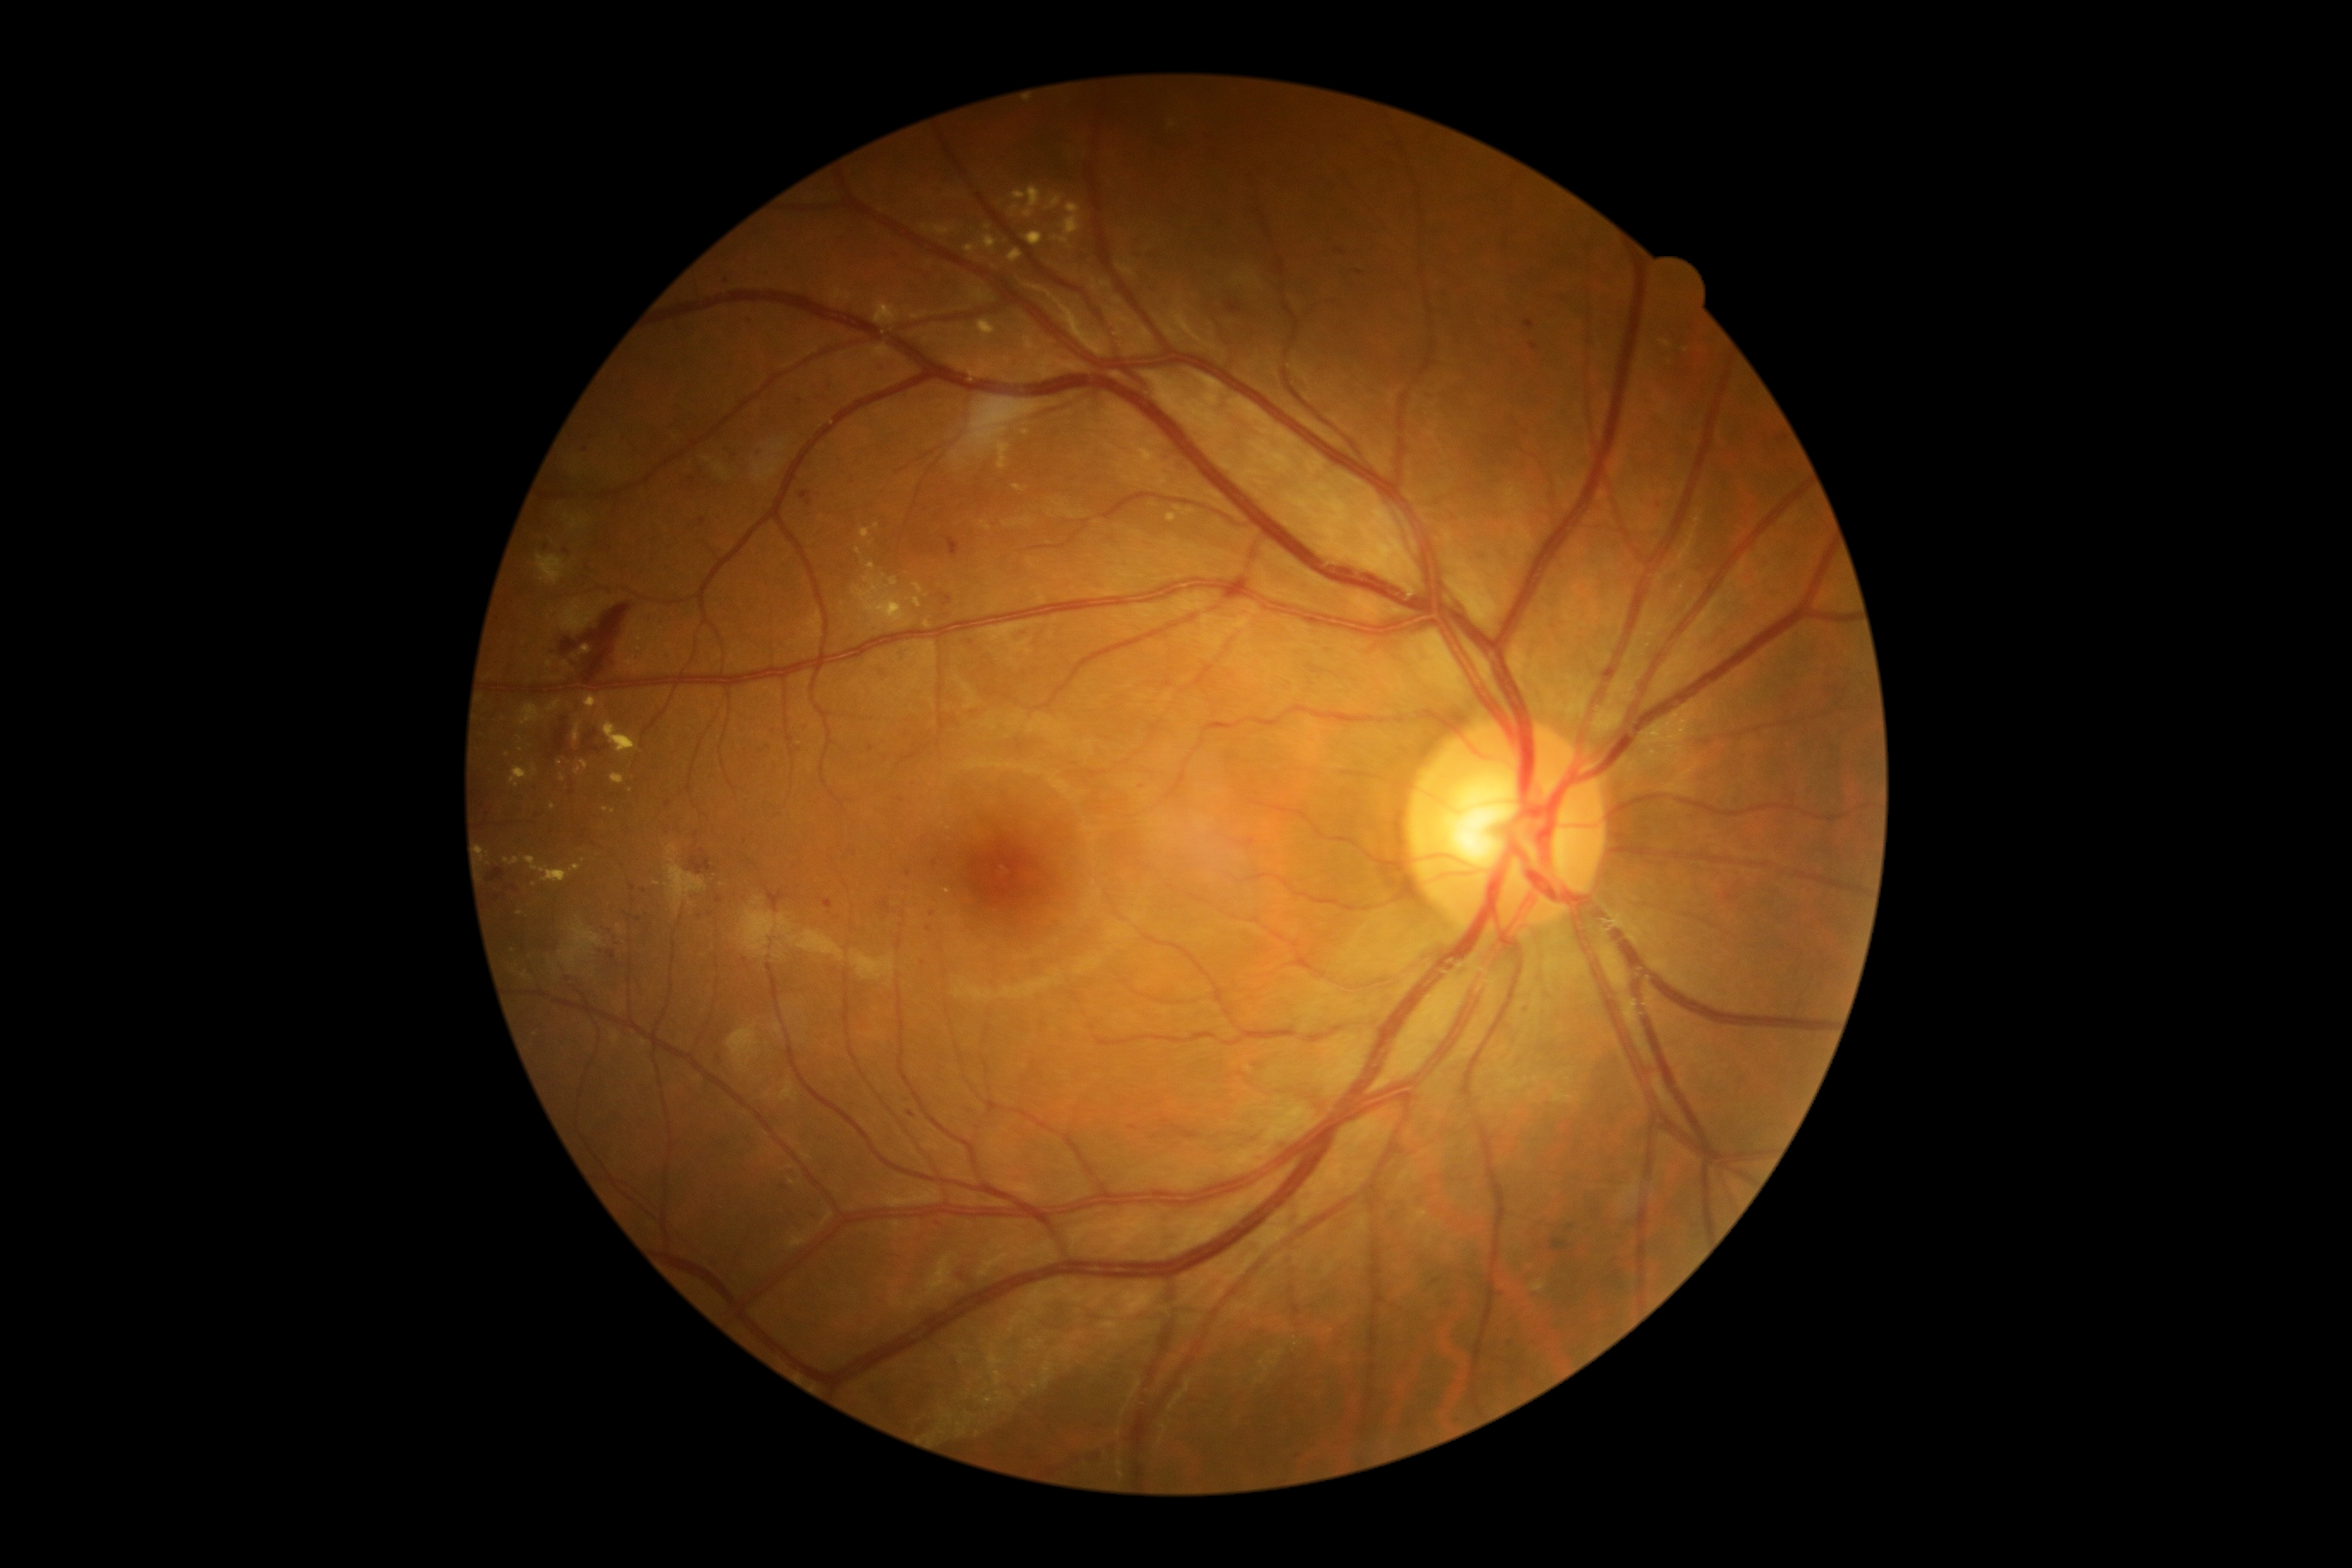 {"partial":true,"dr_grade":2,"dr_grade_name":"moderate NPDR","lesions":{"ex":[[1051,204,1082,245],[1012,205,1020,214],[585,699,604,709],[1137,450,1155,467],[548,701,561,713],[520,704,541,726],[580,646,592,656],[1026,233,1043,247],[560,775,567,783],[1014,188,1043,217],[965,245,976,254]],"ex_small_approx":[[583,860],[605,809],[883,577],[987,227]]}}